No pharmacologic dilation; 848 x 848 pixels; color fundus photograph; 45° FOV — 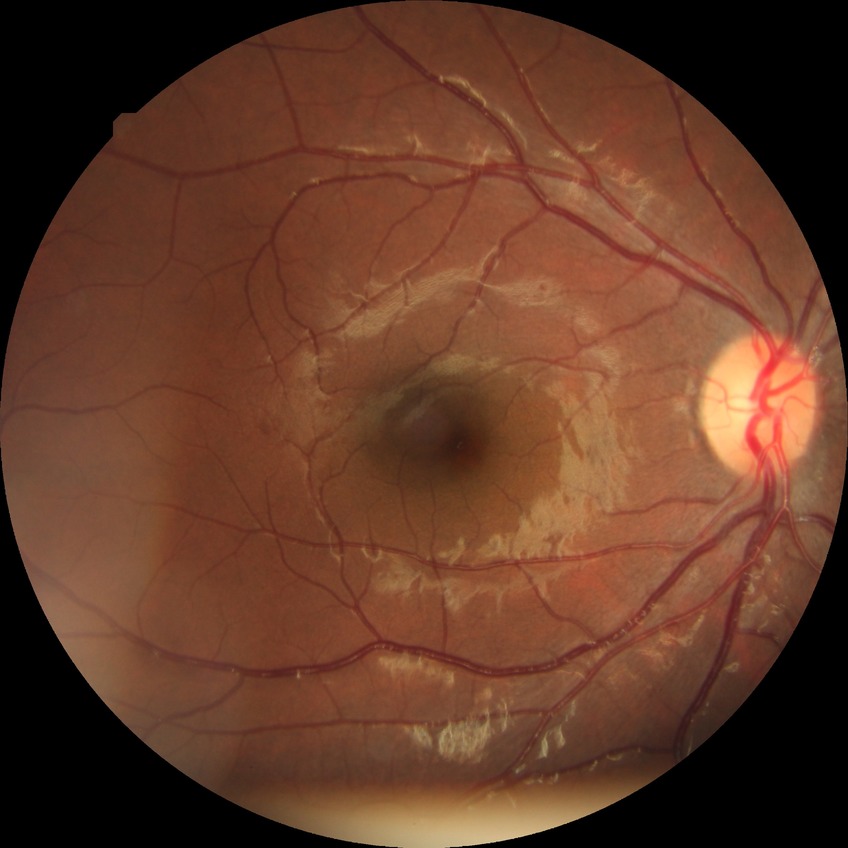
retinopathy grade: simple diabetic retinopathy.